Posterior pole color fundus photograph, FOV: 45 degrees, camera: NIDEK AFC-230, nonmydriatic fundus photograph, diabetic retinopathy graded by the modified Davis classification: 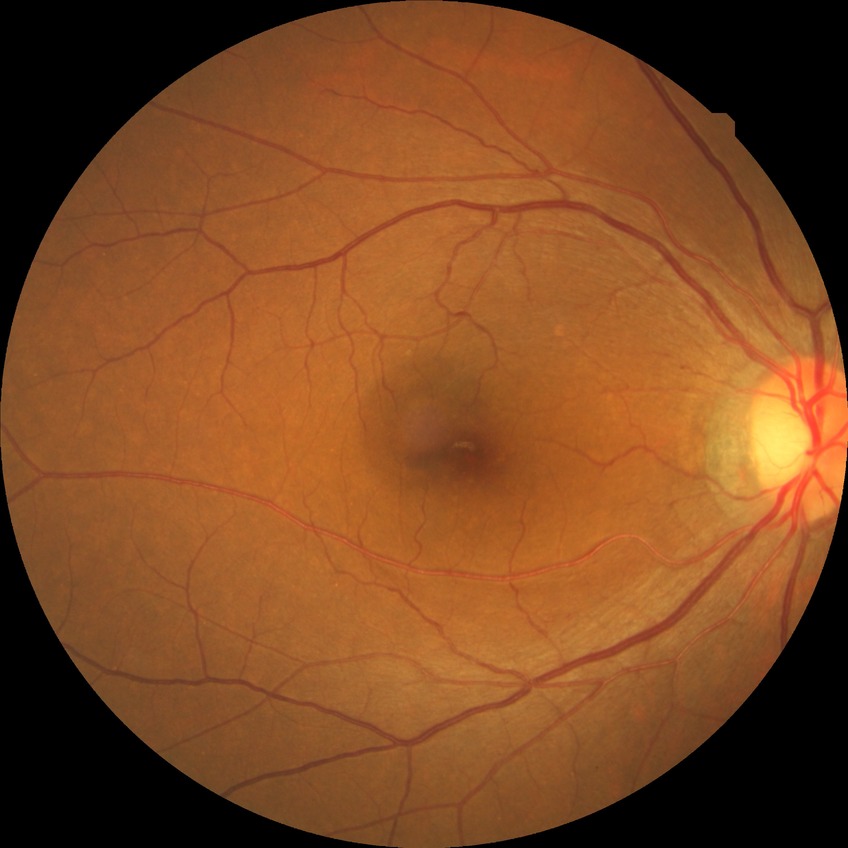

modified Davis grade: NDR.